Wide-field fundus photograph of an infant
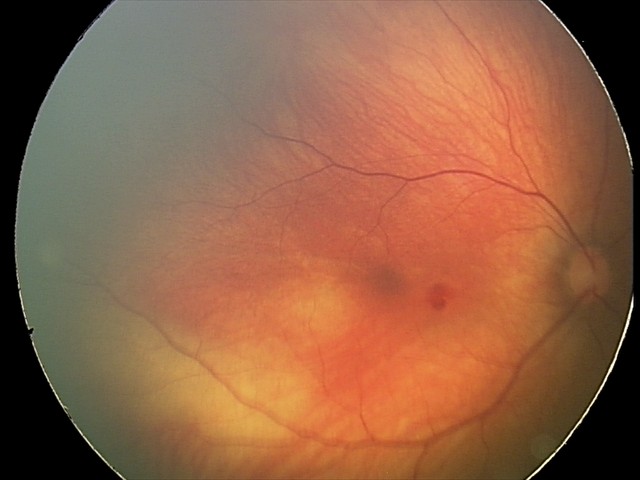

Diagnosis from this screening exam: retinal hemorrhages.